2352 x 1568 pixels: 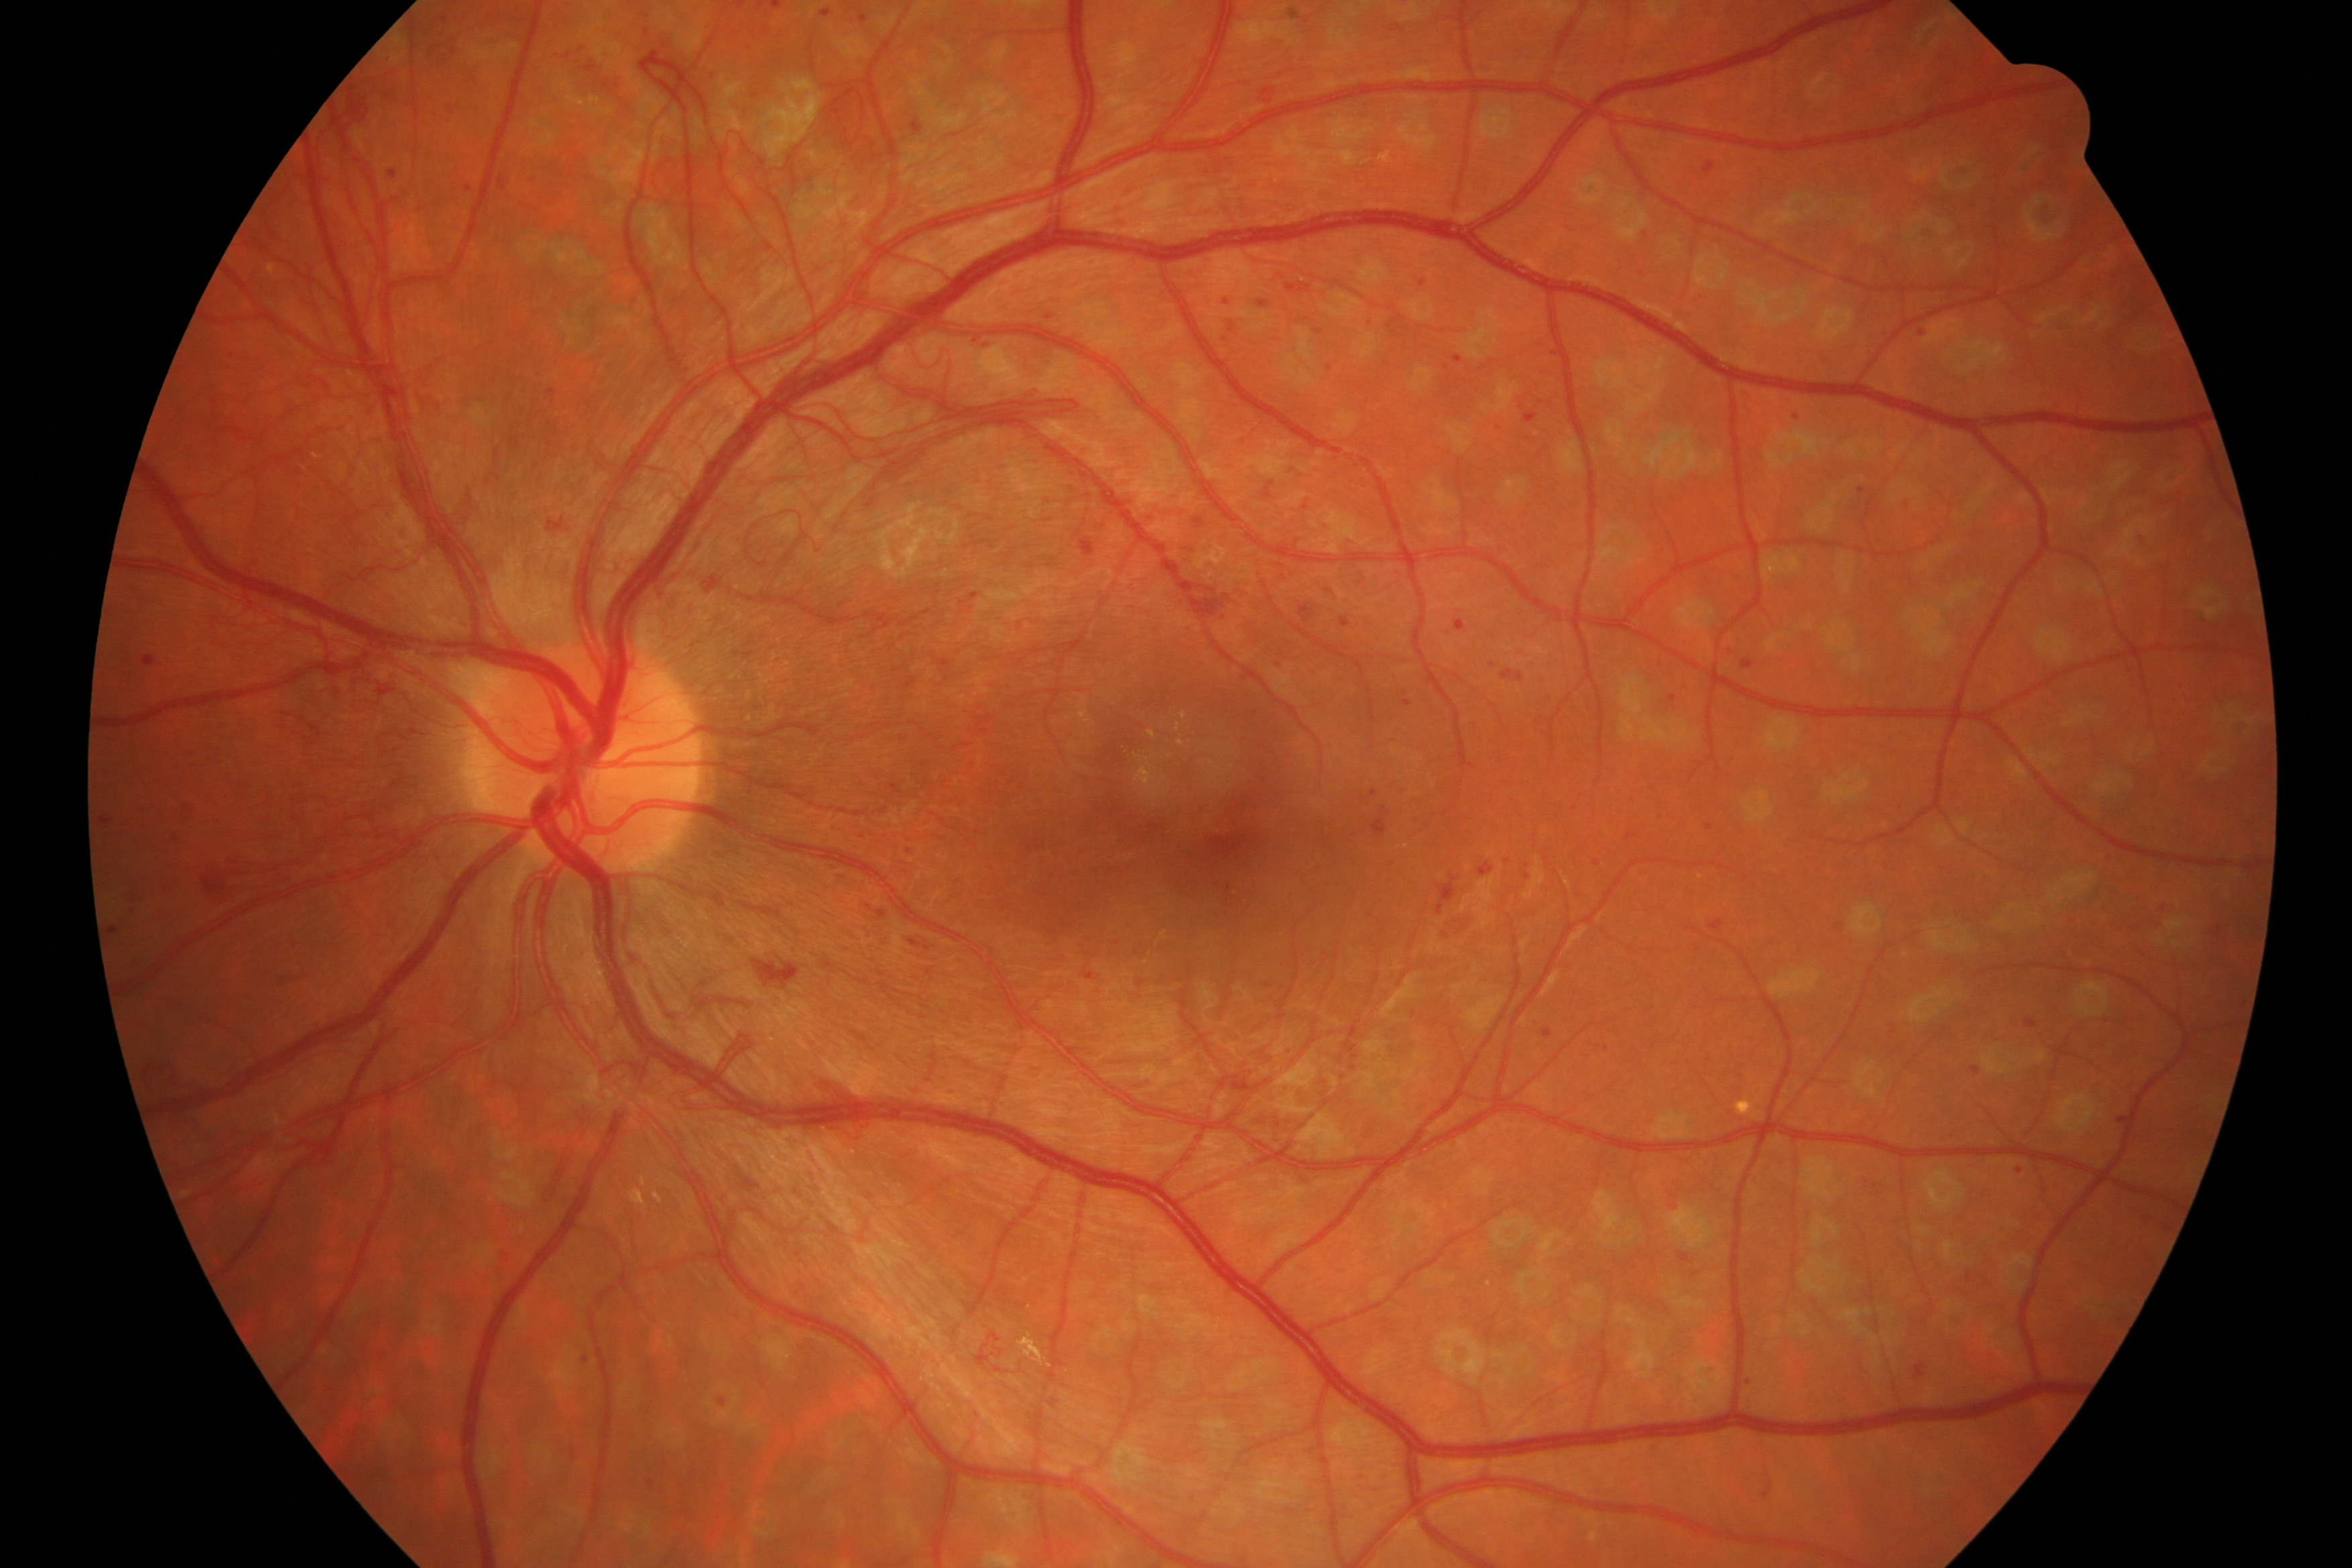 Pathology: DR.